2352 by 1568 pixels · color fundus photograph:
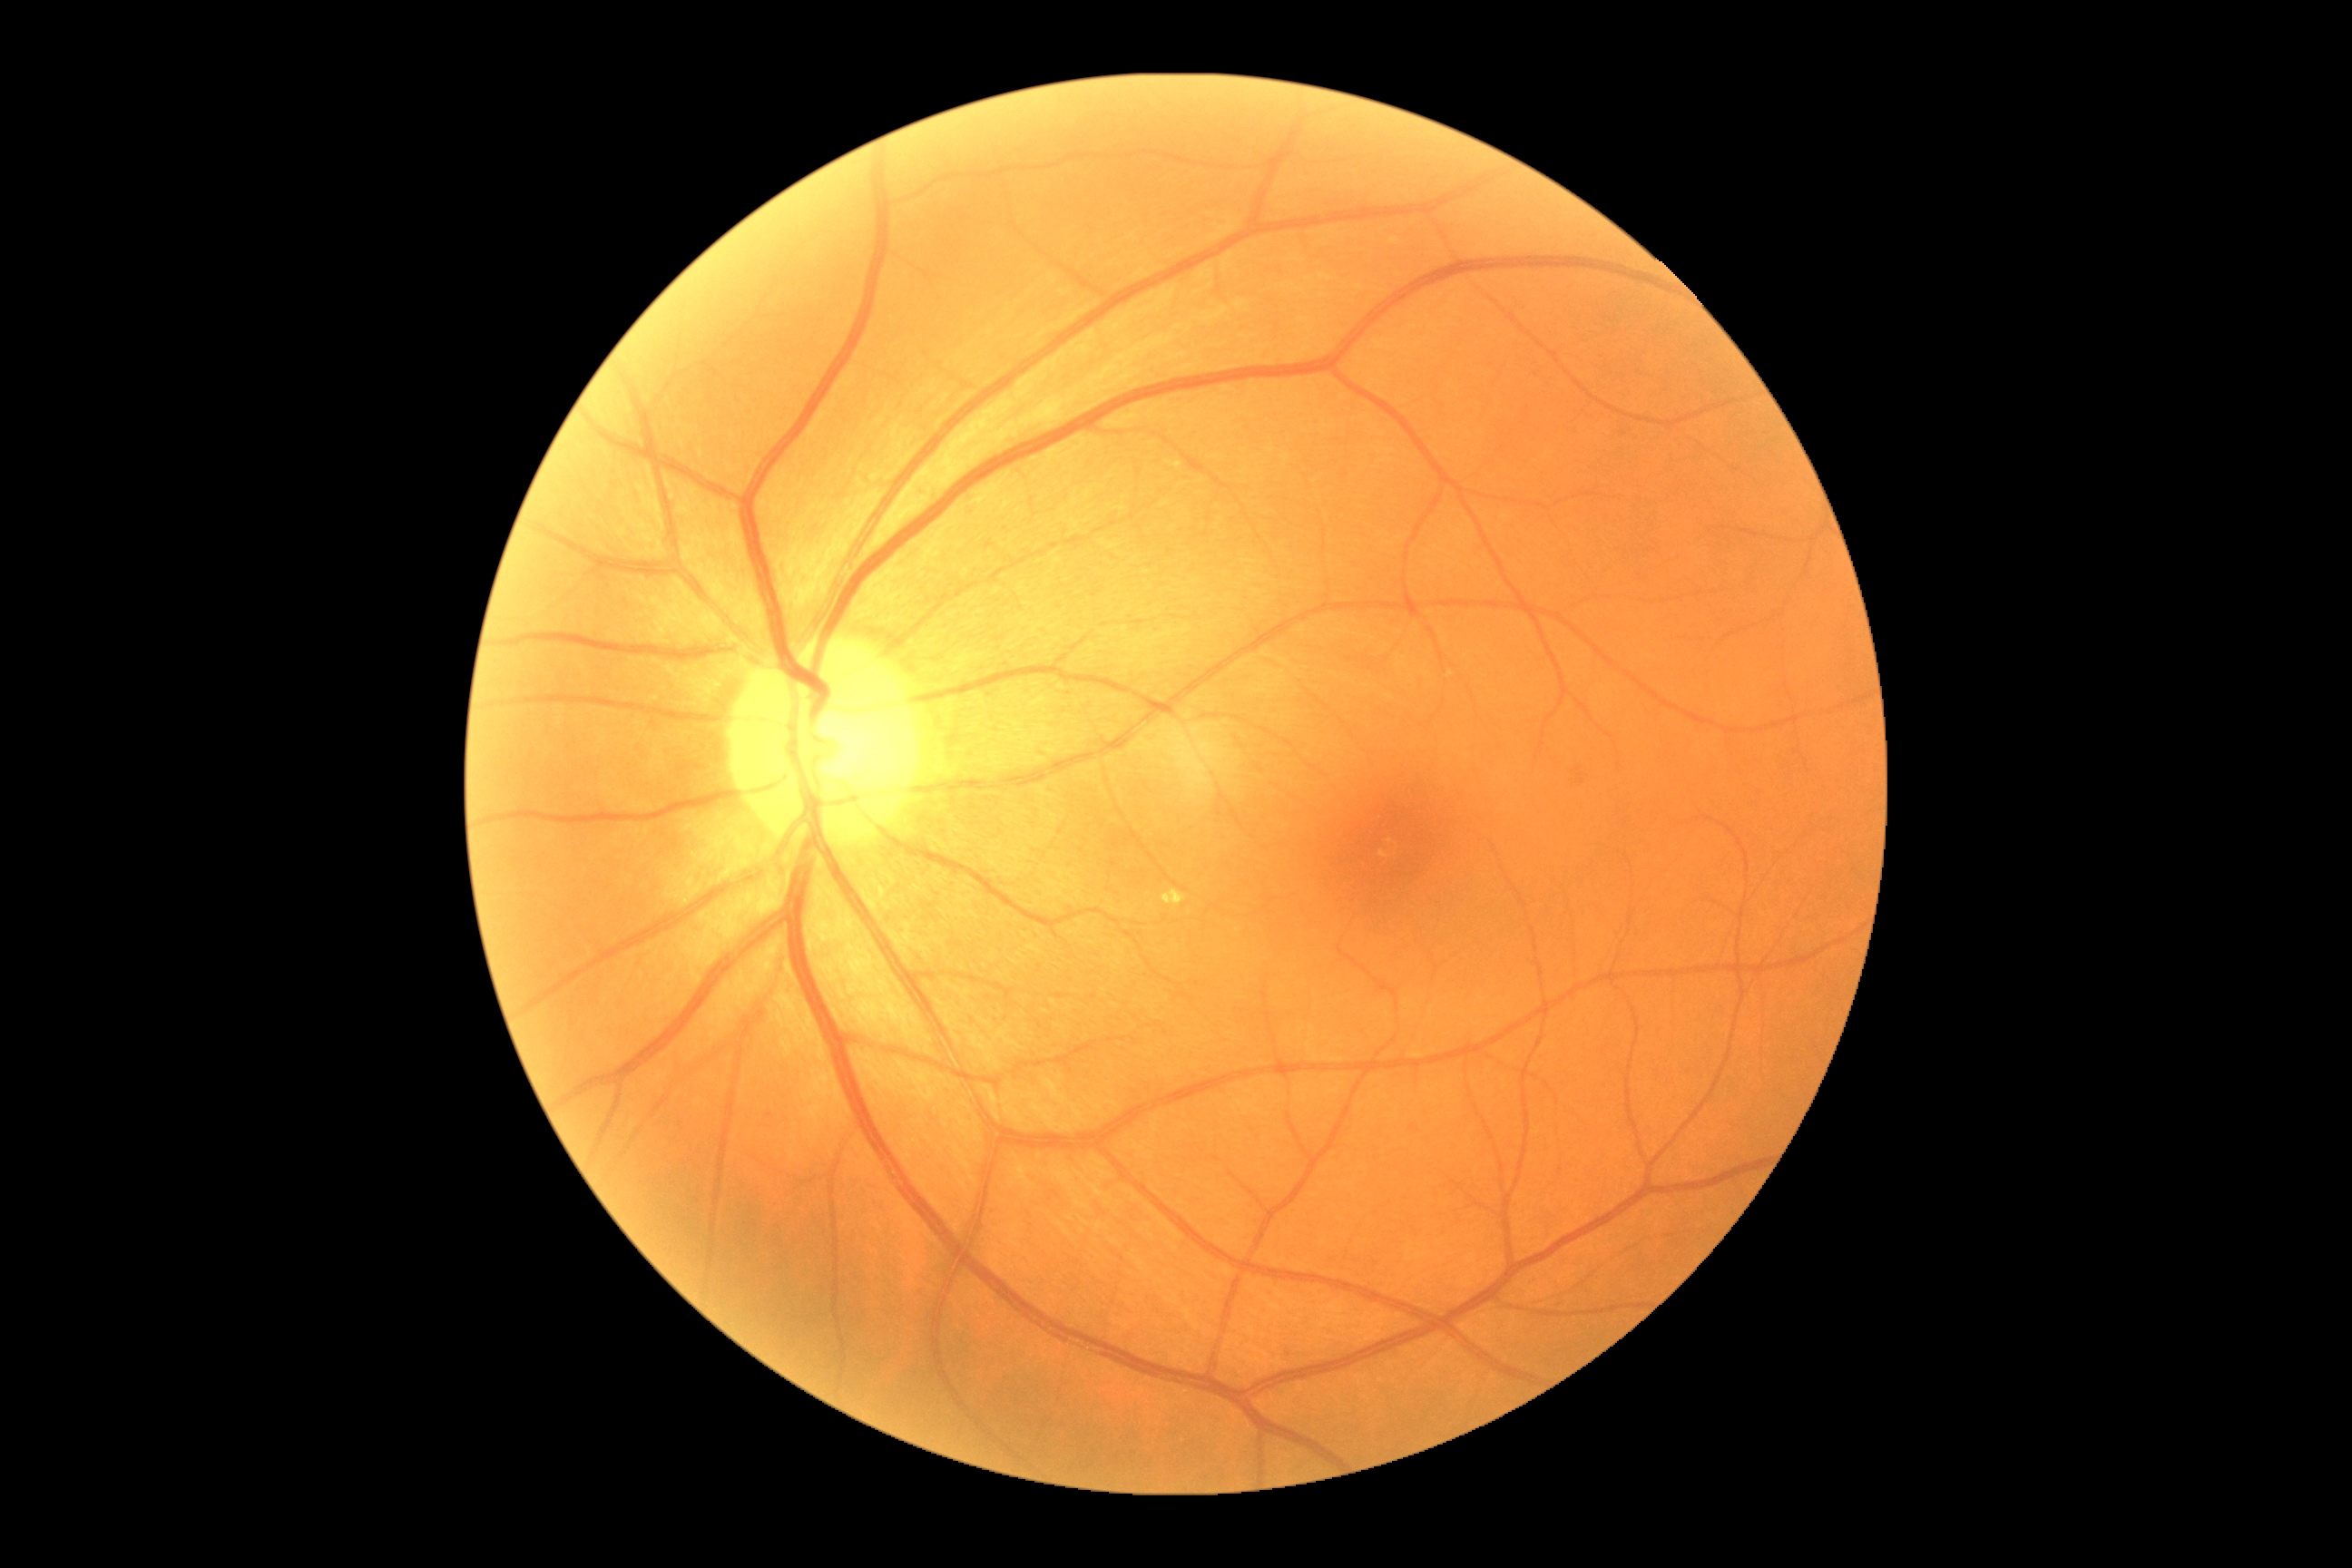 Diabetic retinopathy: moderate NPDR (grade 2).